Without pupil dilation, camera: NIDEK AFC-230 — 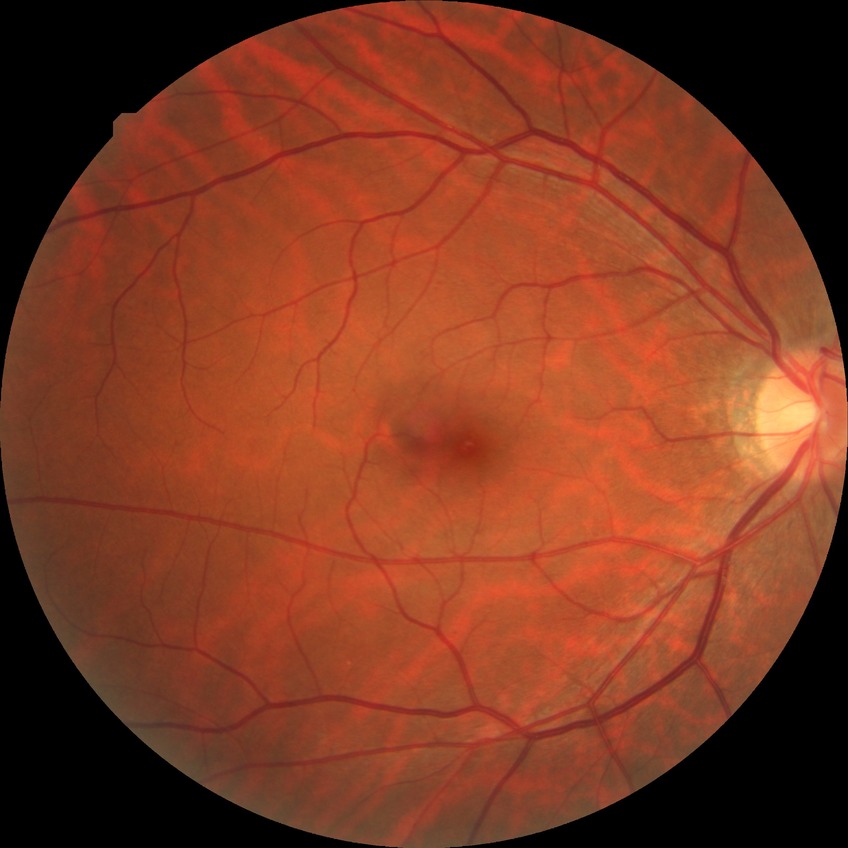 Diabetic retinopathy (DR) is simple diabetic retinopathy (SDR).